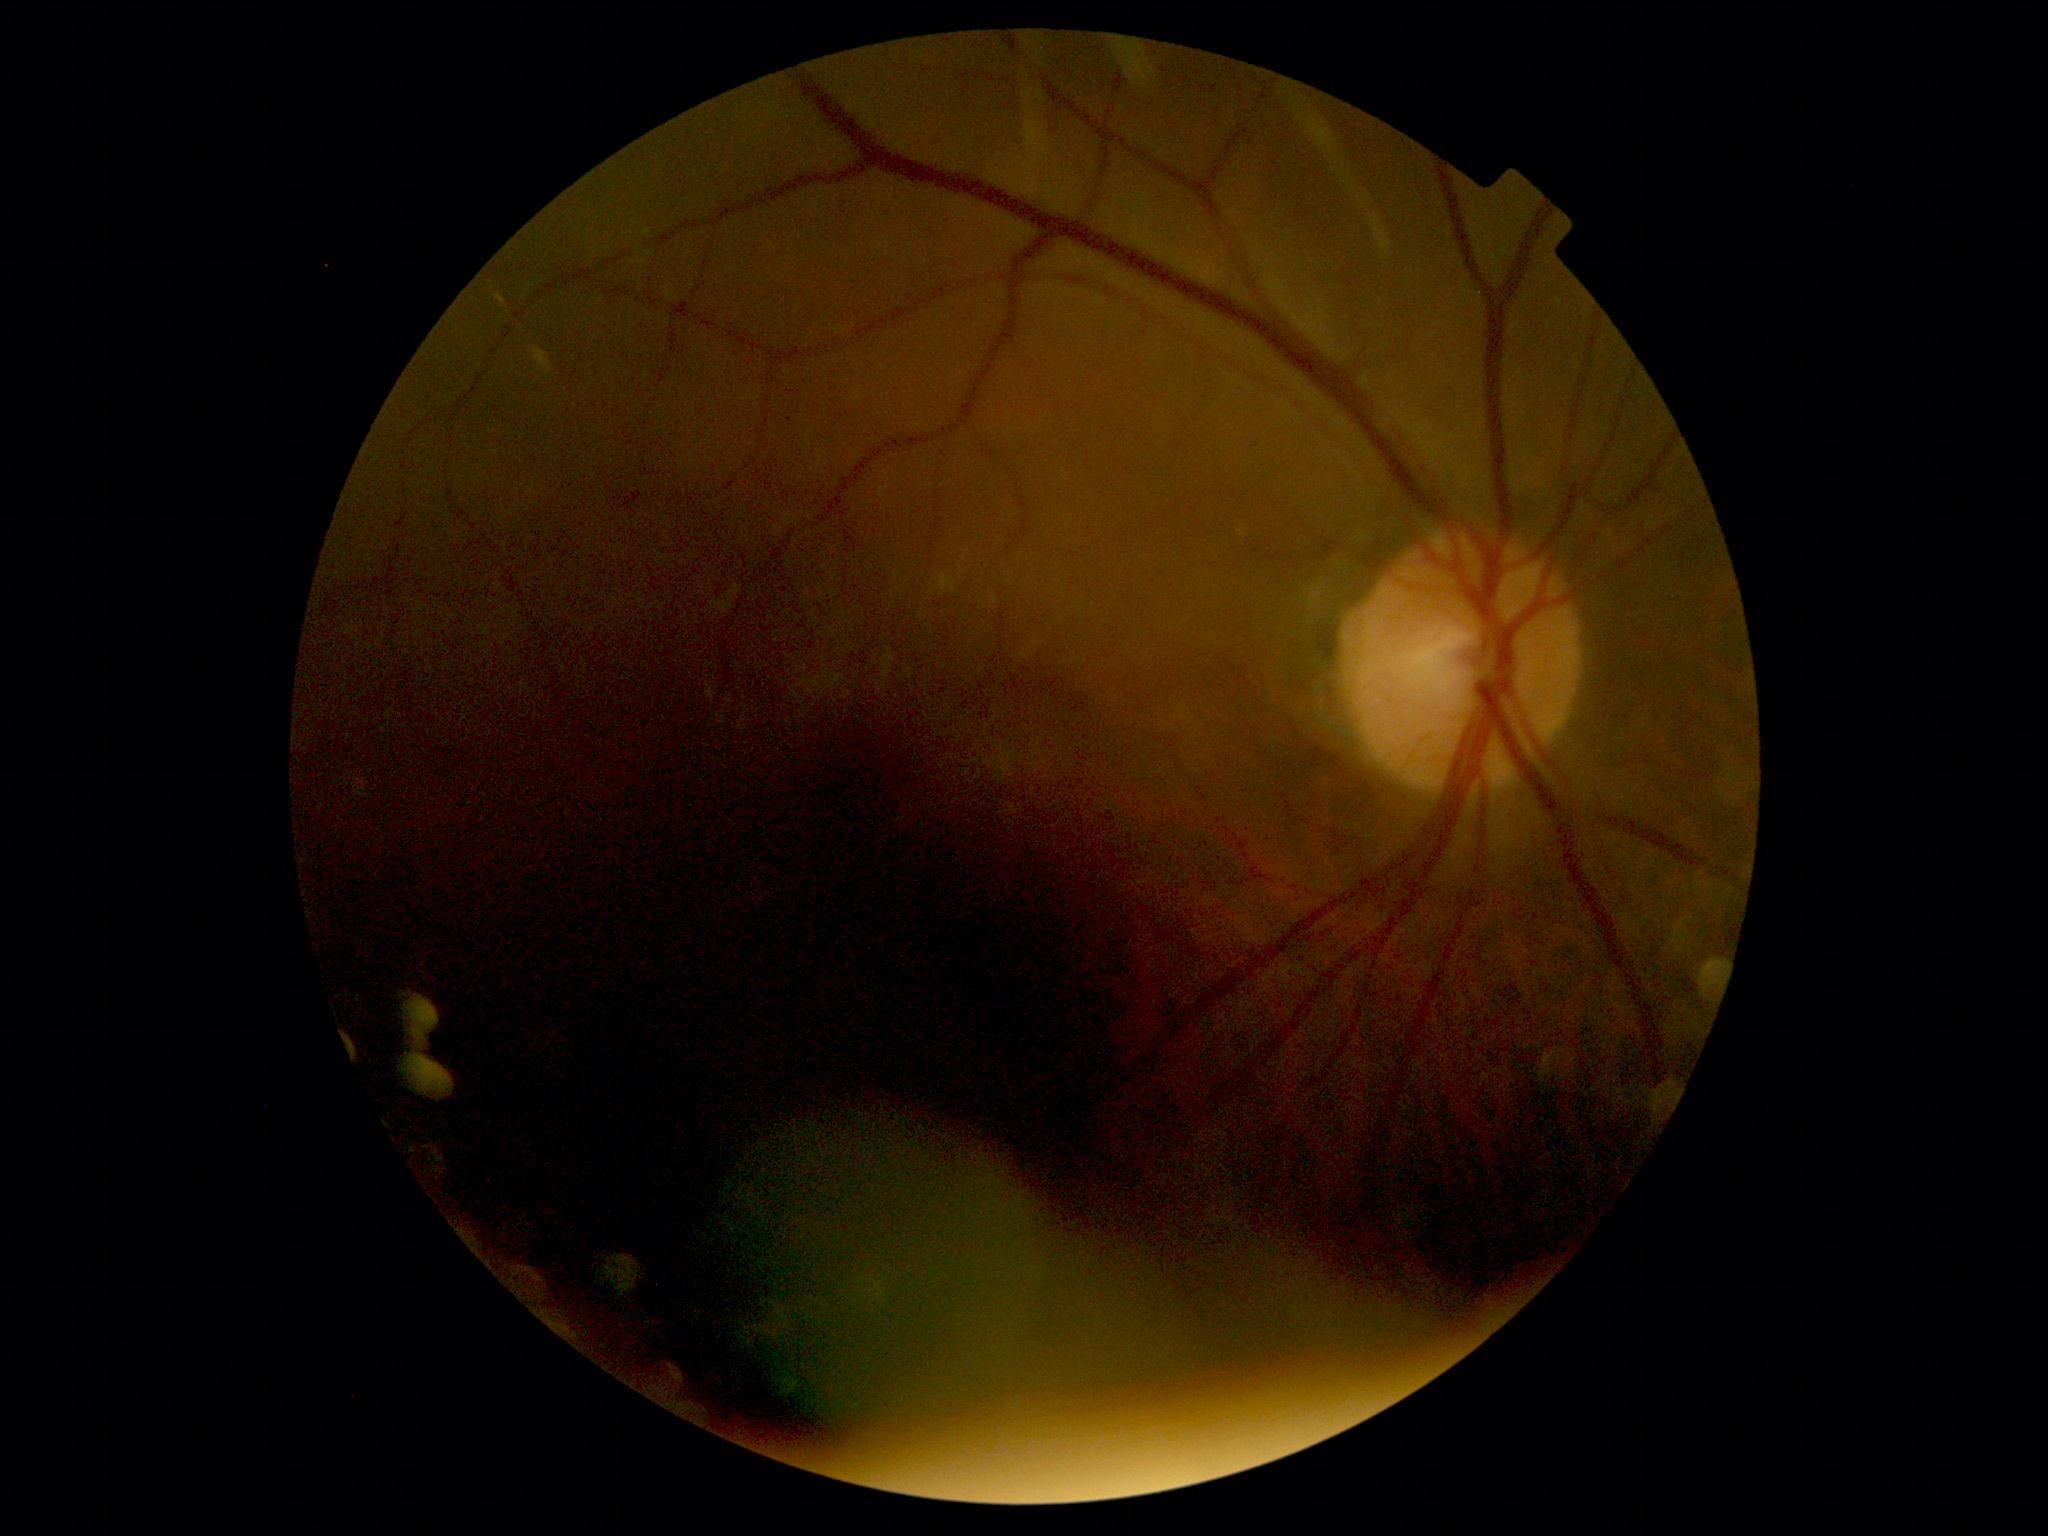
DR severity: ungradable.